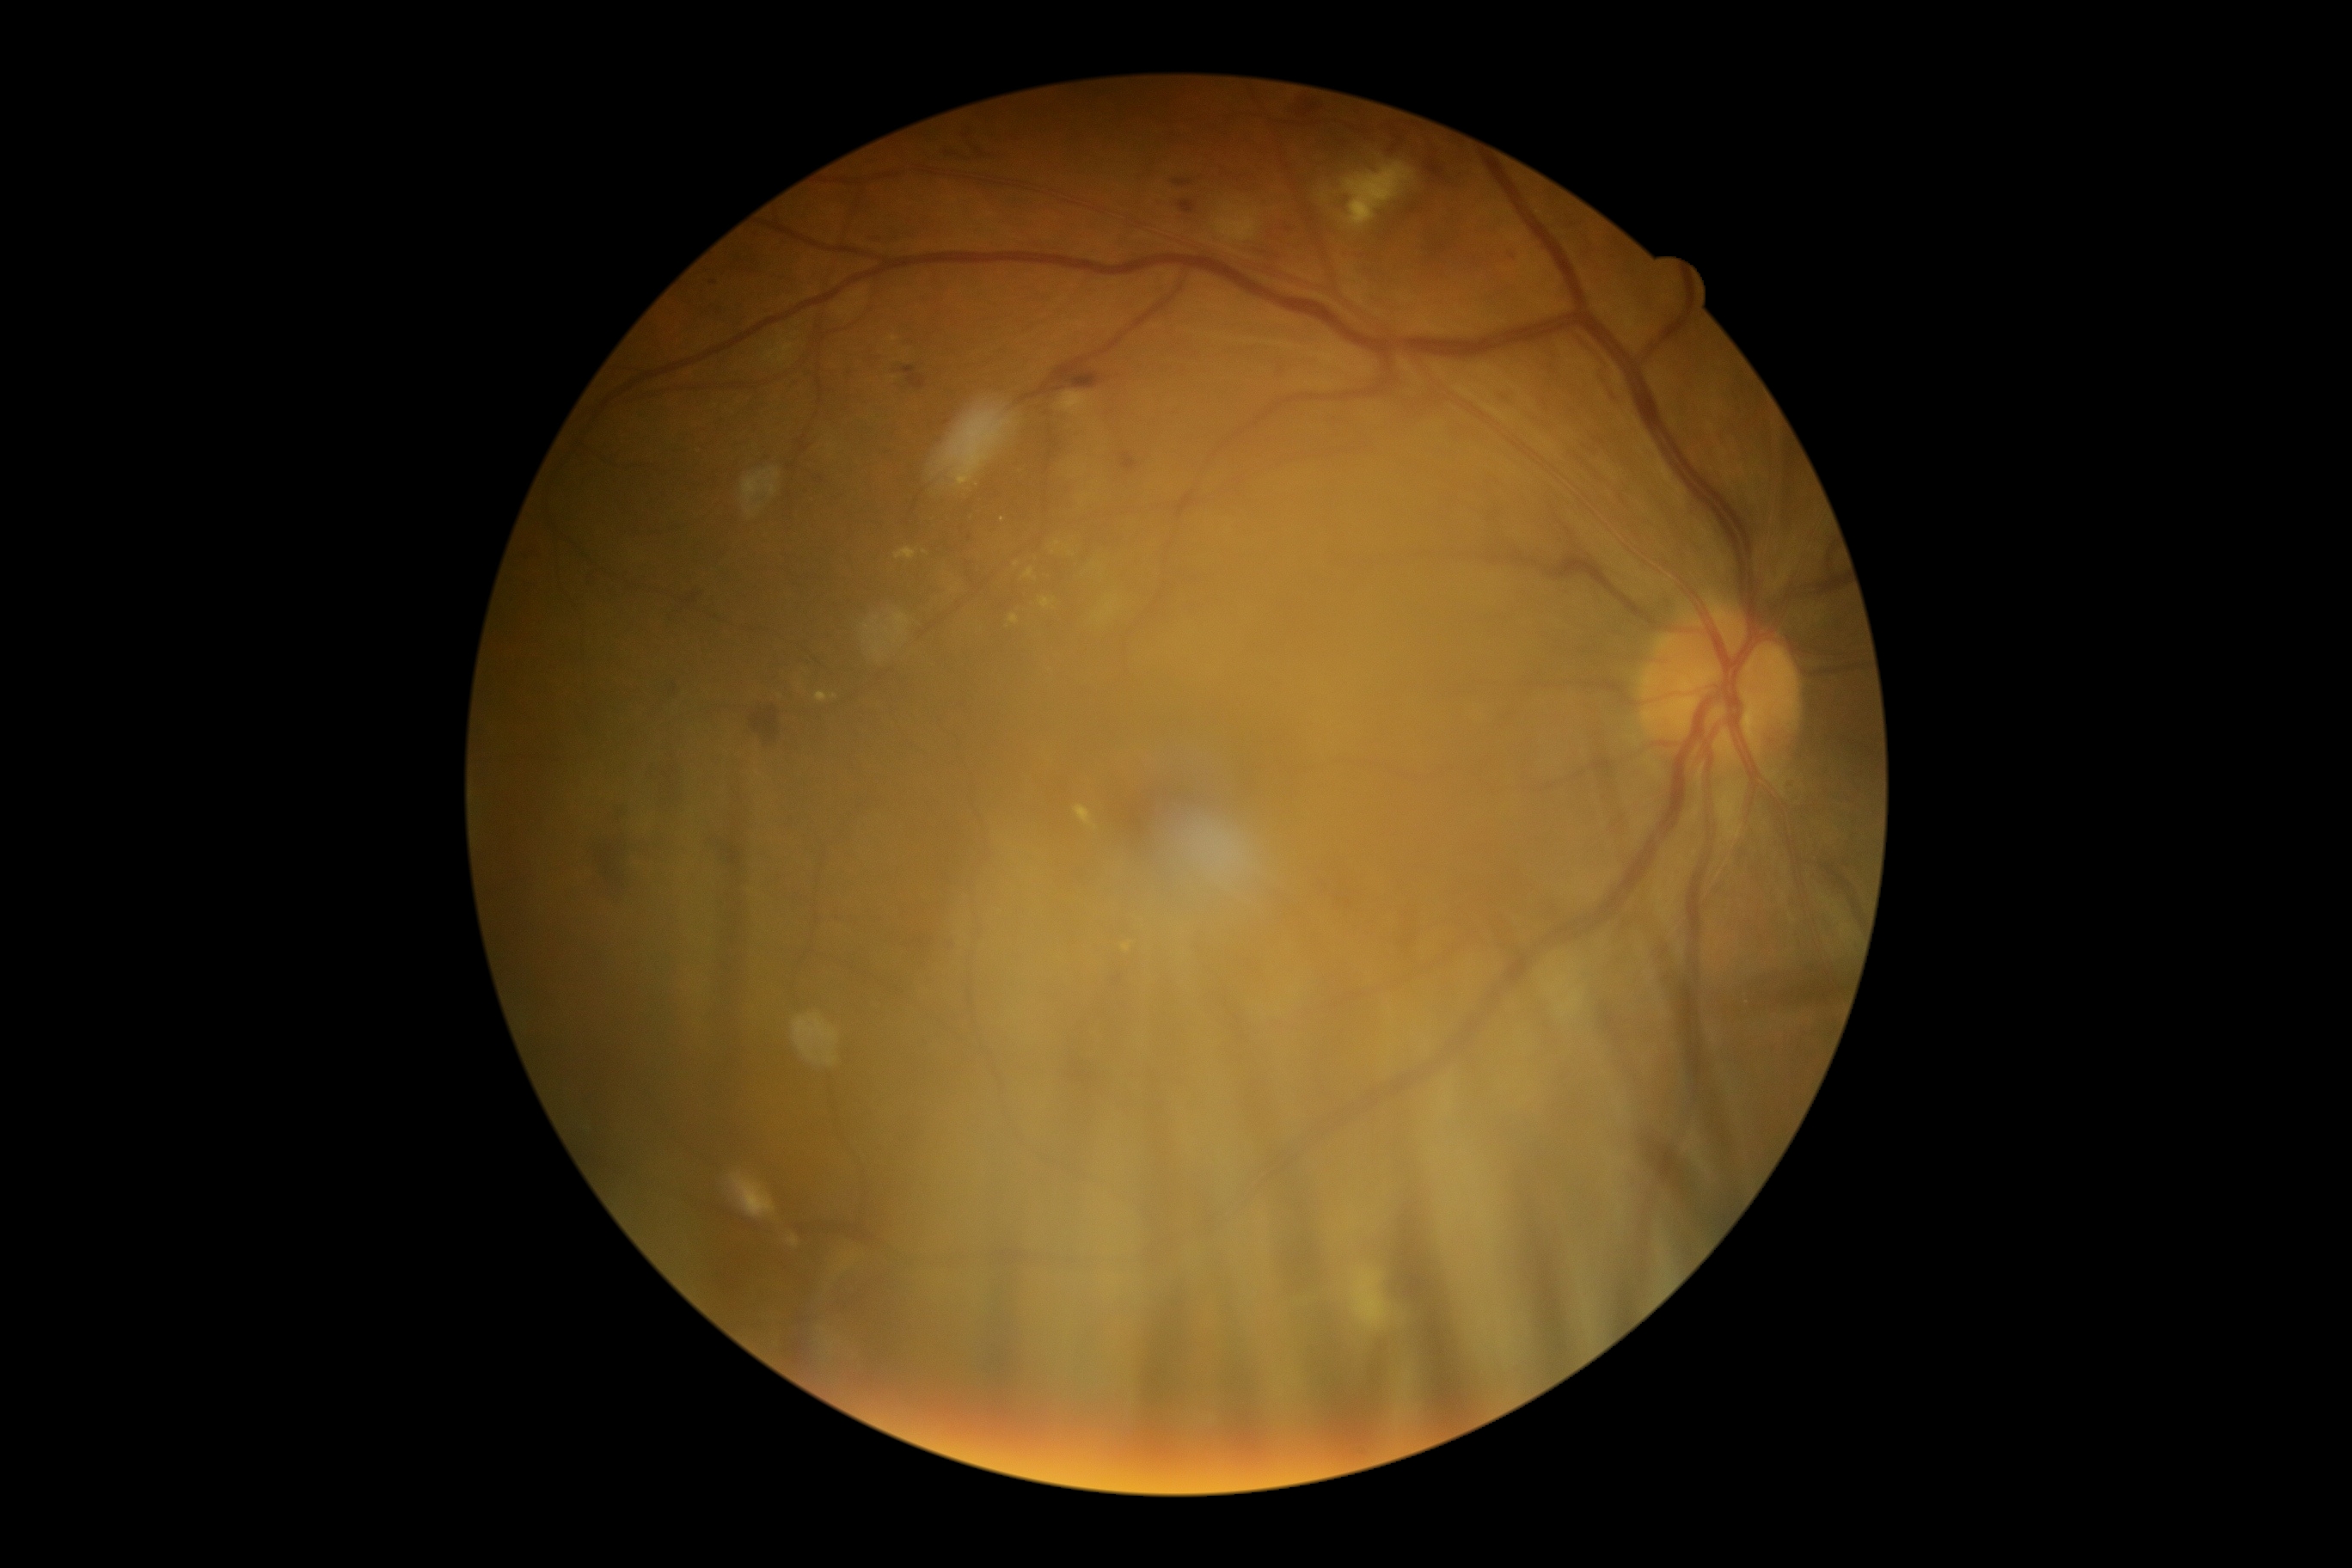
DR@2 — more than just microaneurysms but less than severe NPDR.